Fundus photo; graded on the modified Davis scale; 848x848: 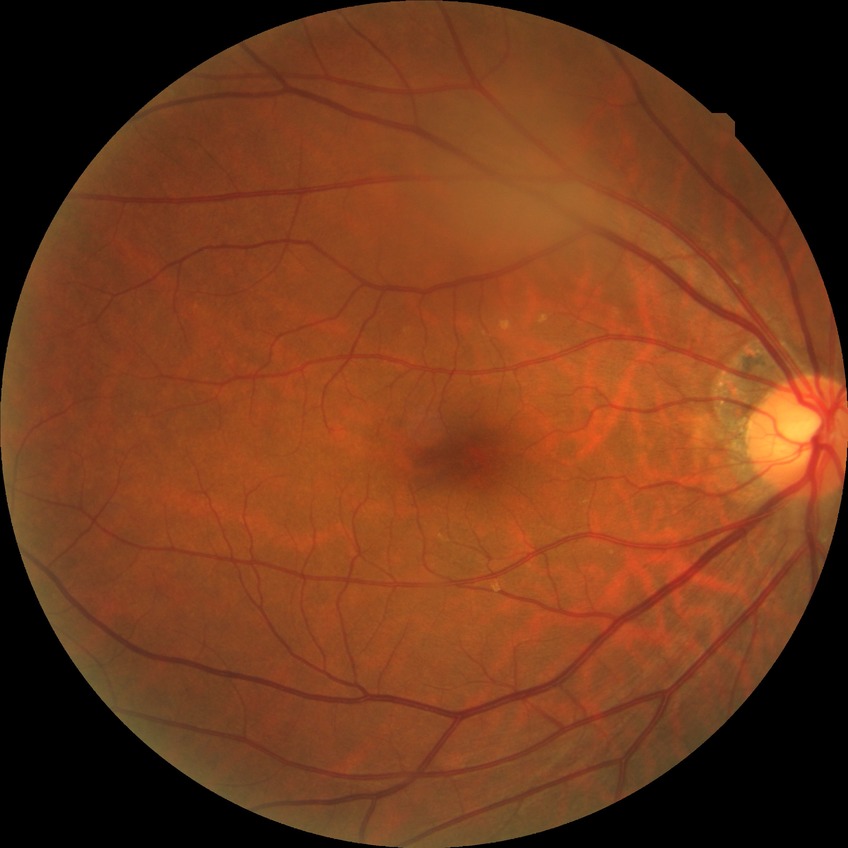
Diabetic retinopathy (DR): no diabetic retinopathy (NDR).